FOV: 45 degrees · fundus photo — 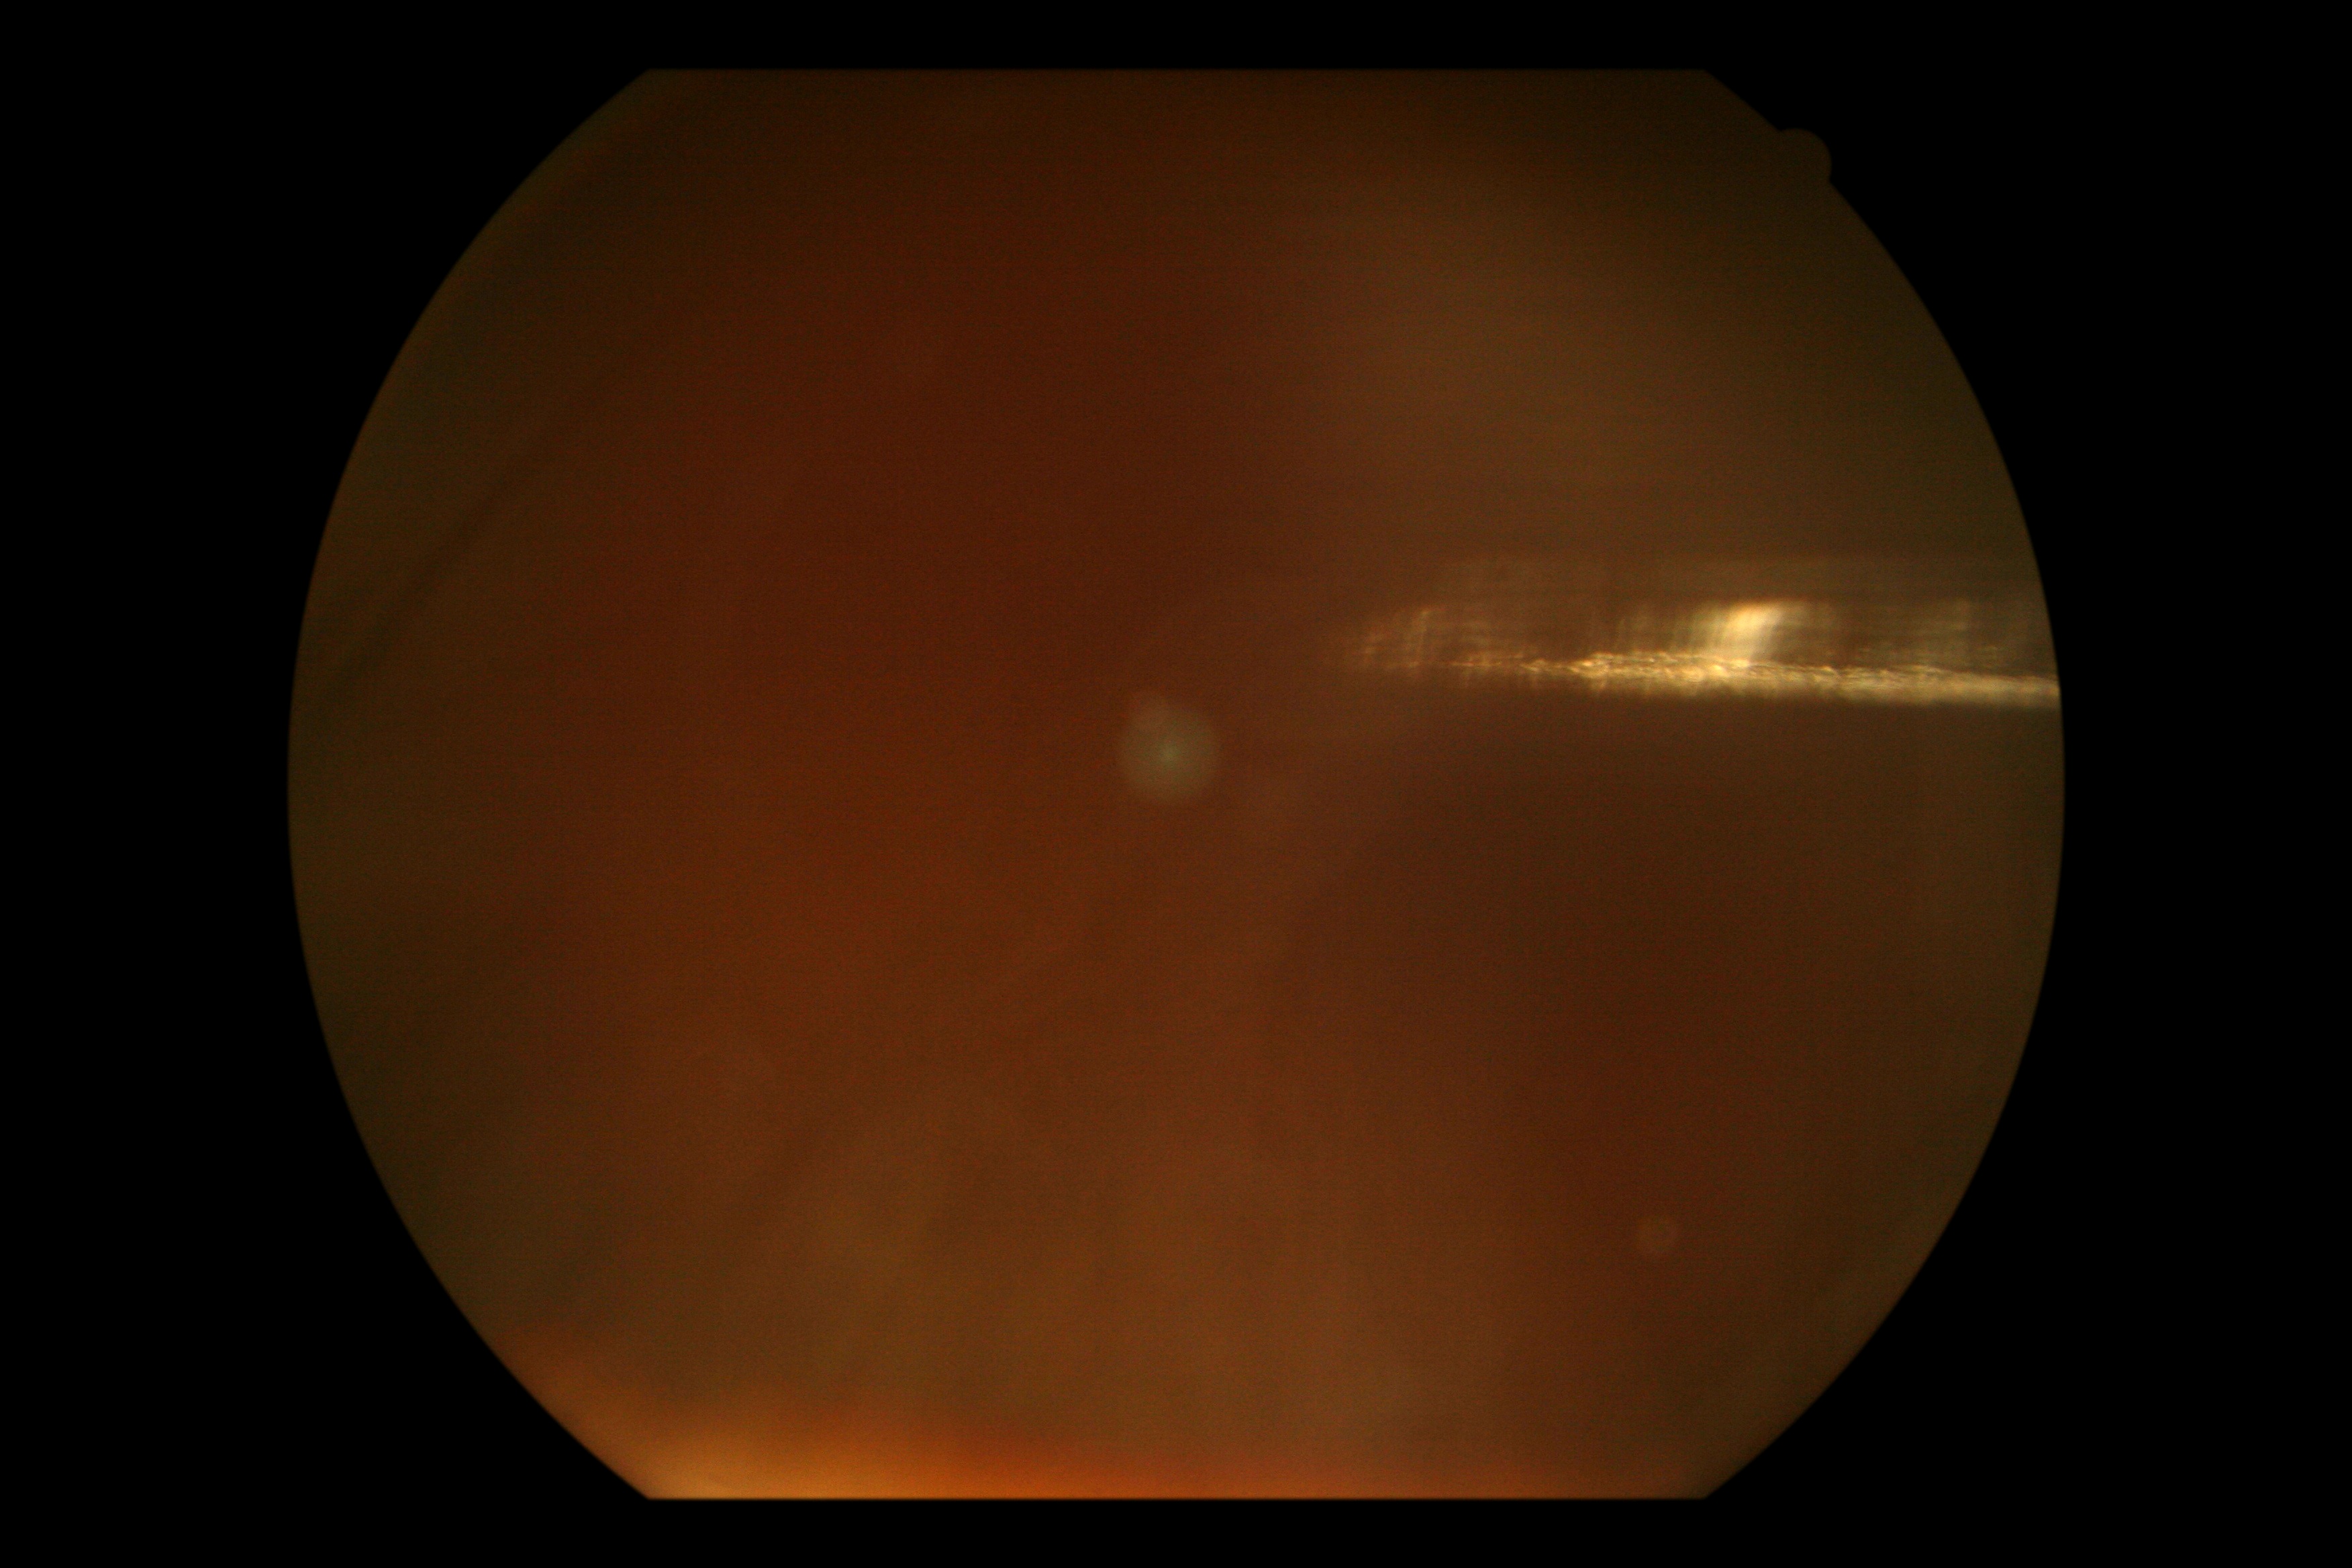

DR severity: ungradable.